45° field of view · modified Davis classification:
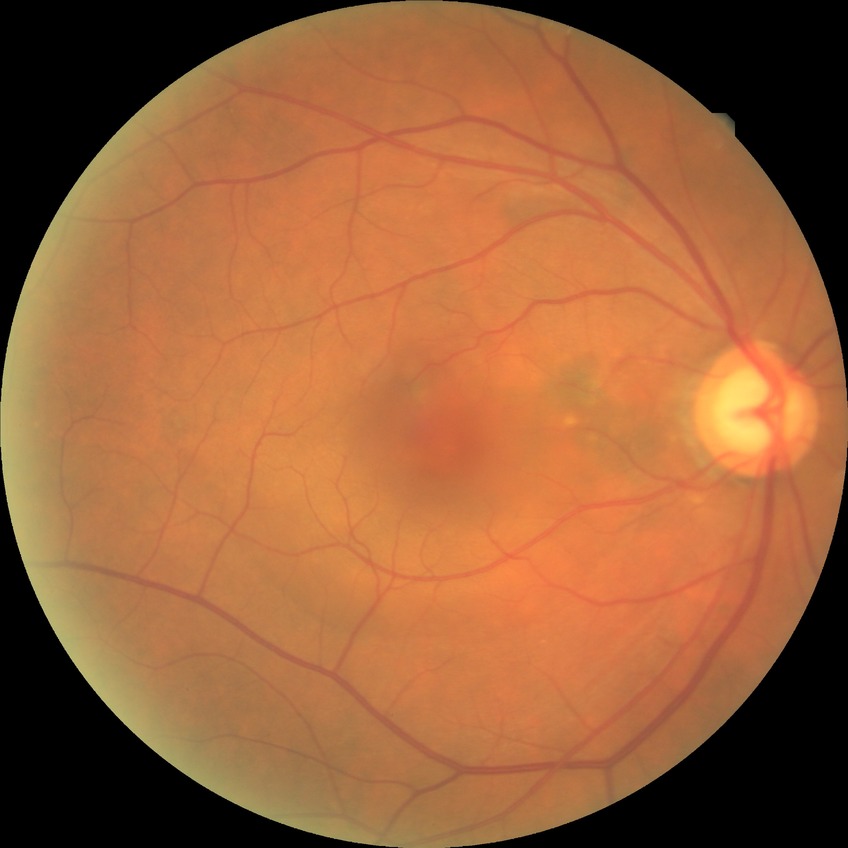
Modified Davis grading is no diabetic retinopathy.